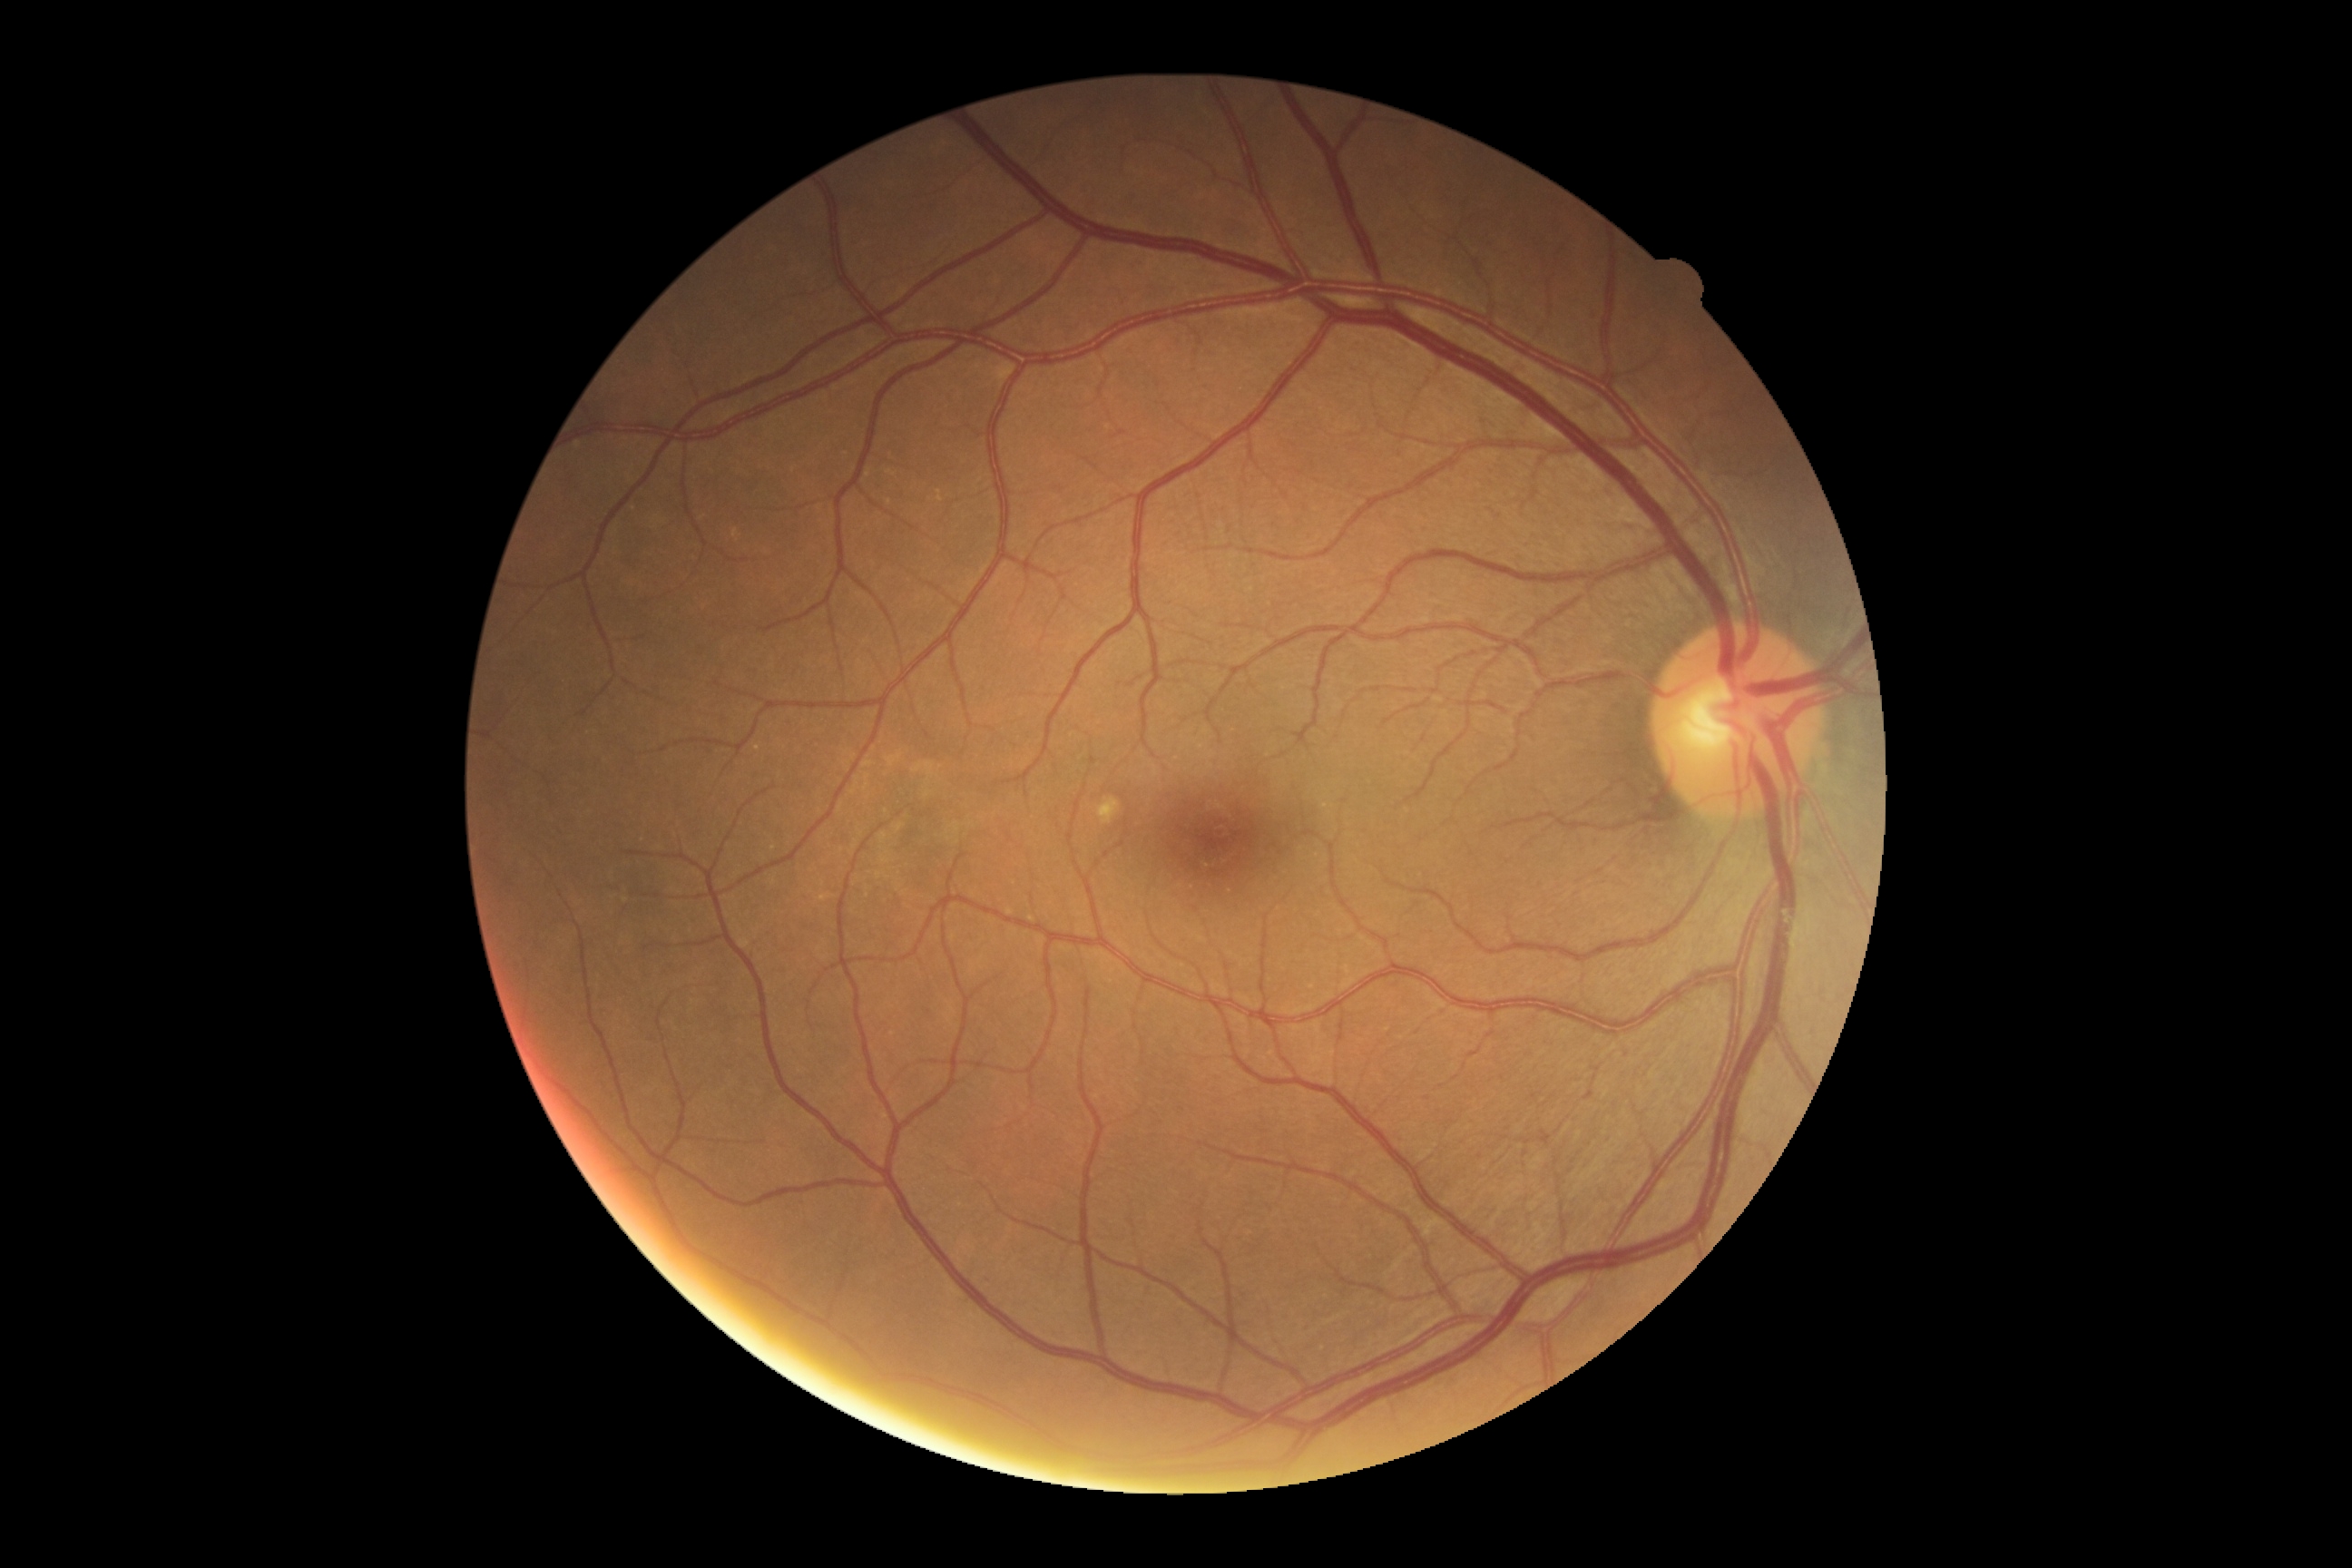

DR severity is no apparent diabetic retinopathy (grade 0).